FOV: 45 degrees: 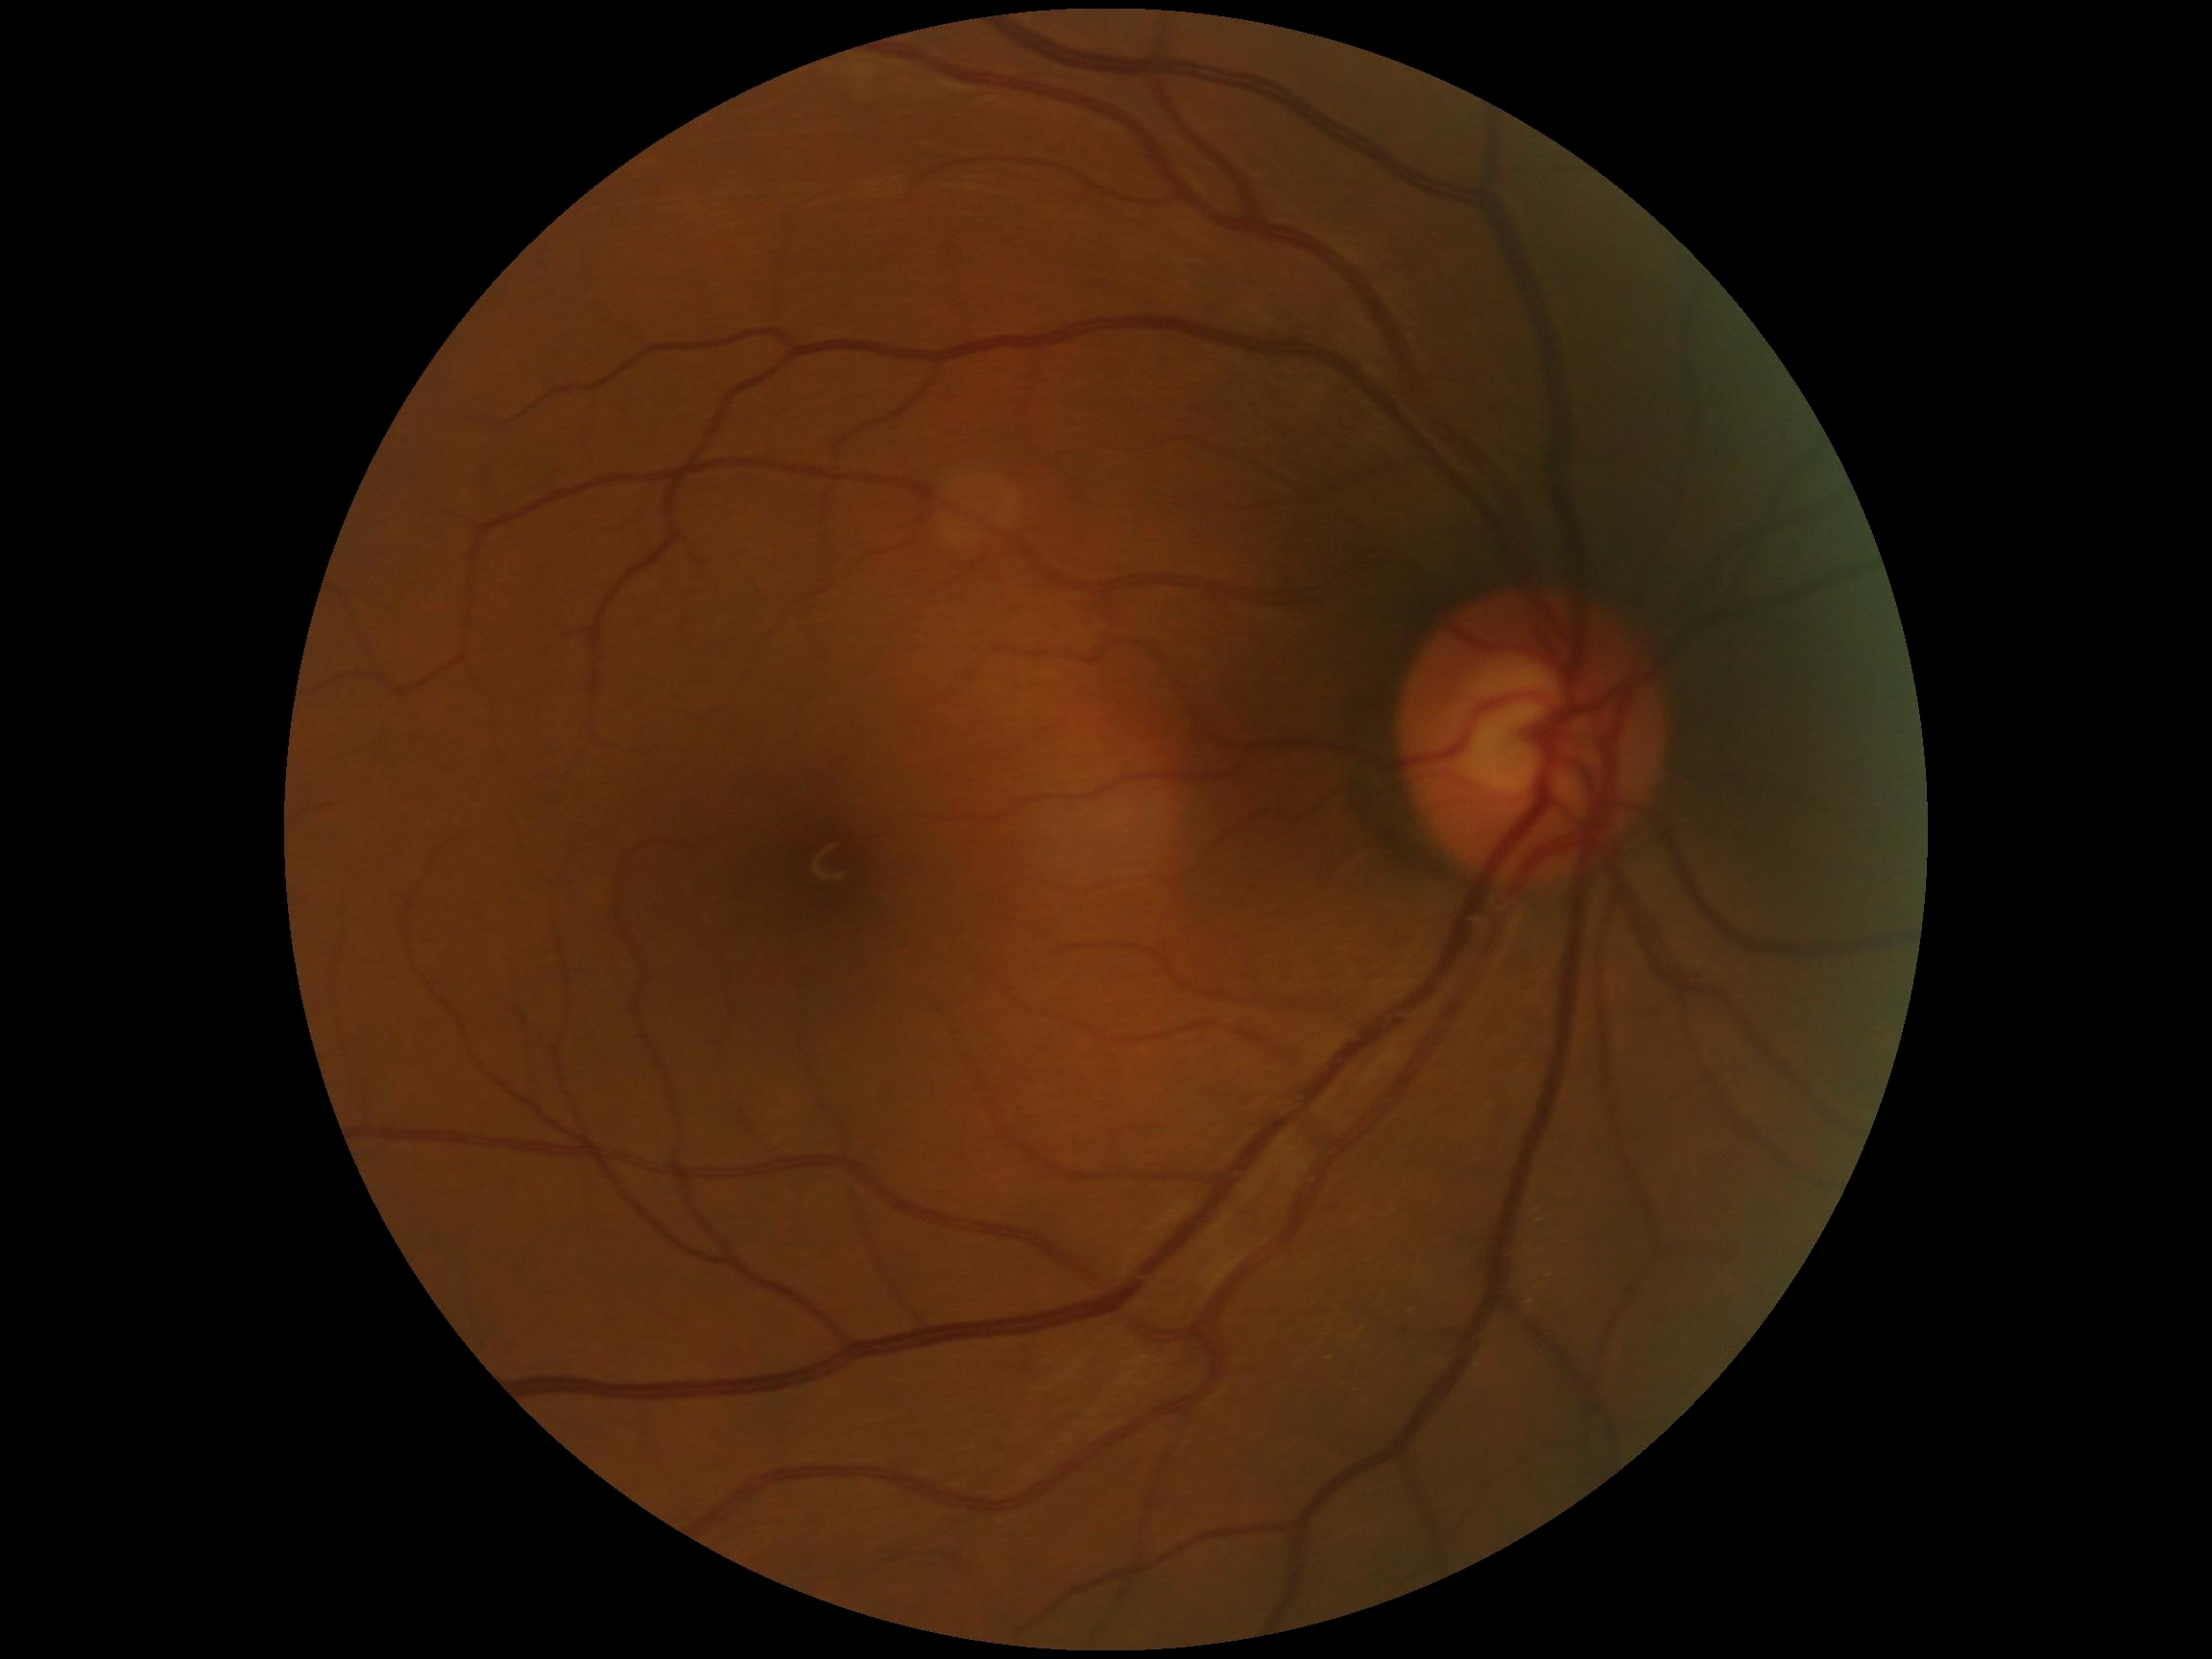 DR severity: 0/4, DR impression: no apparent DR.